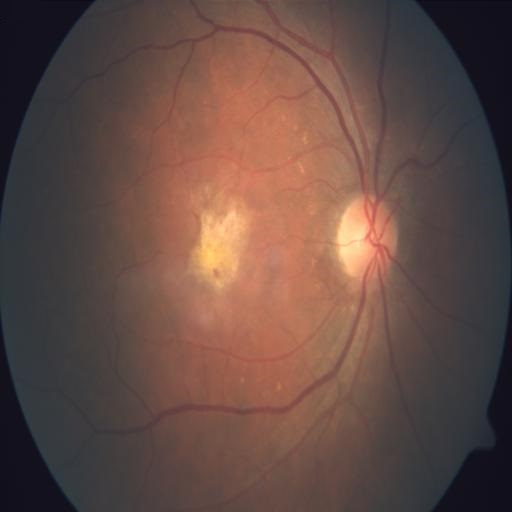 Color fundus photograph showing macular scar.